Color fundus photograph — 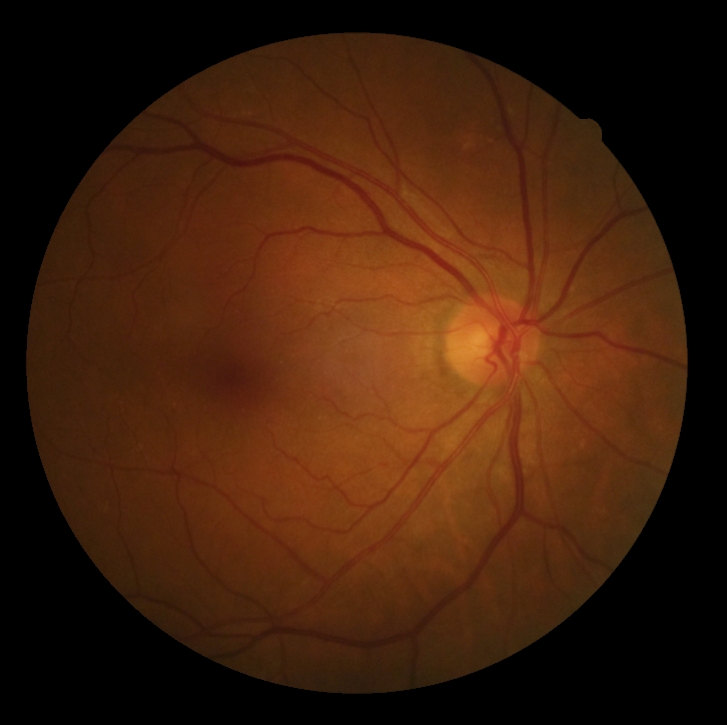
  dr_grade: no apparent retinopathy (0)
  dr_impression: no apparent DR